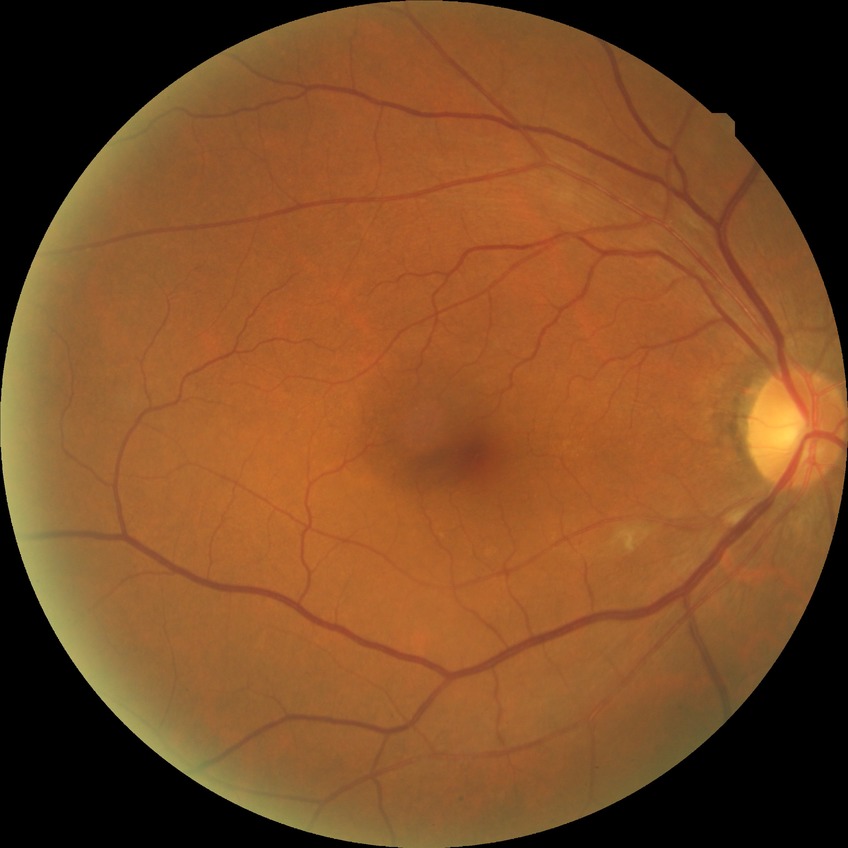

Modified Davis grading: no diabetic retinopathy.